1659x2212
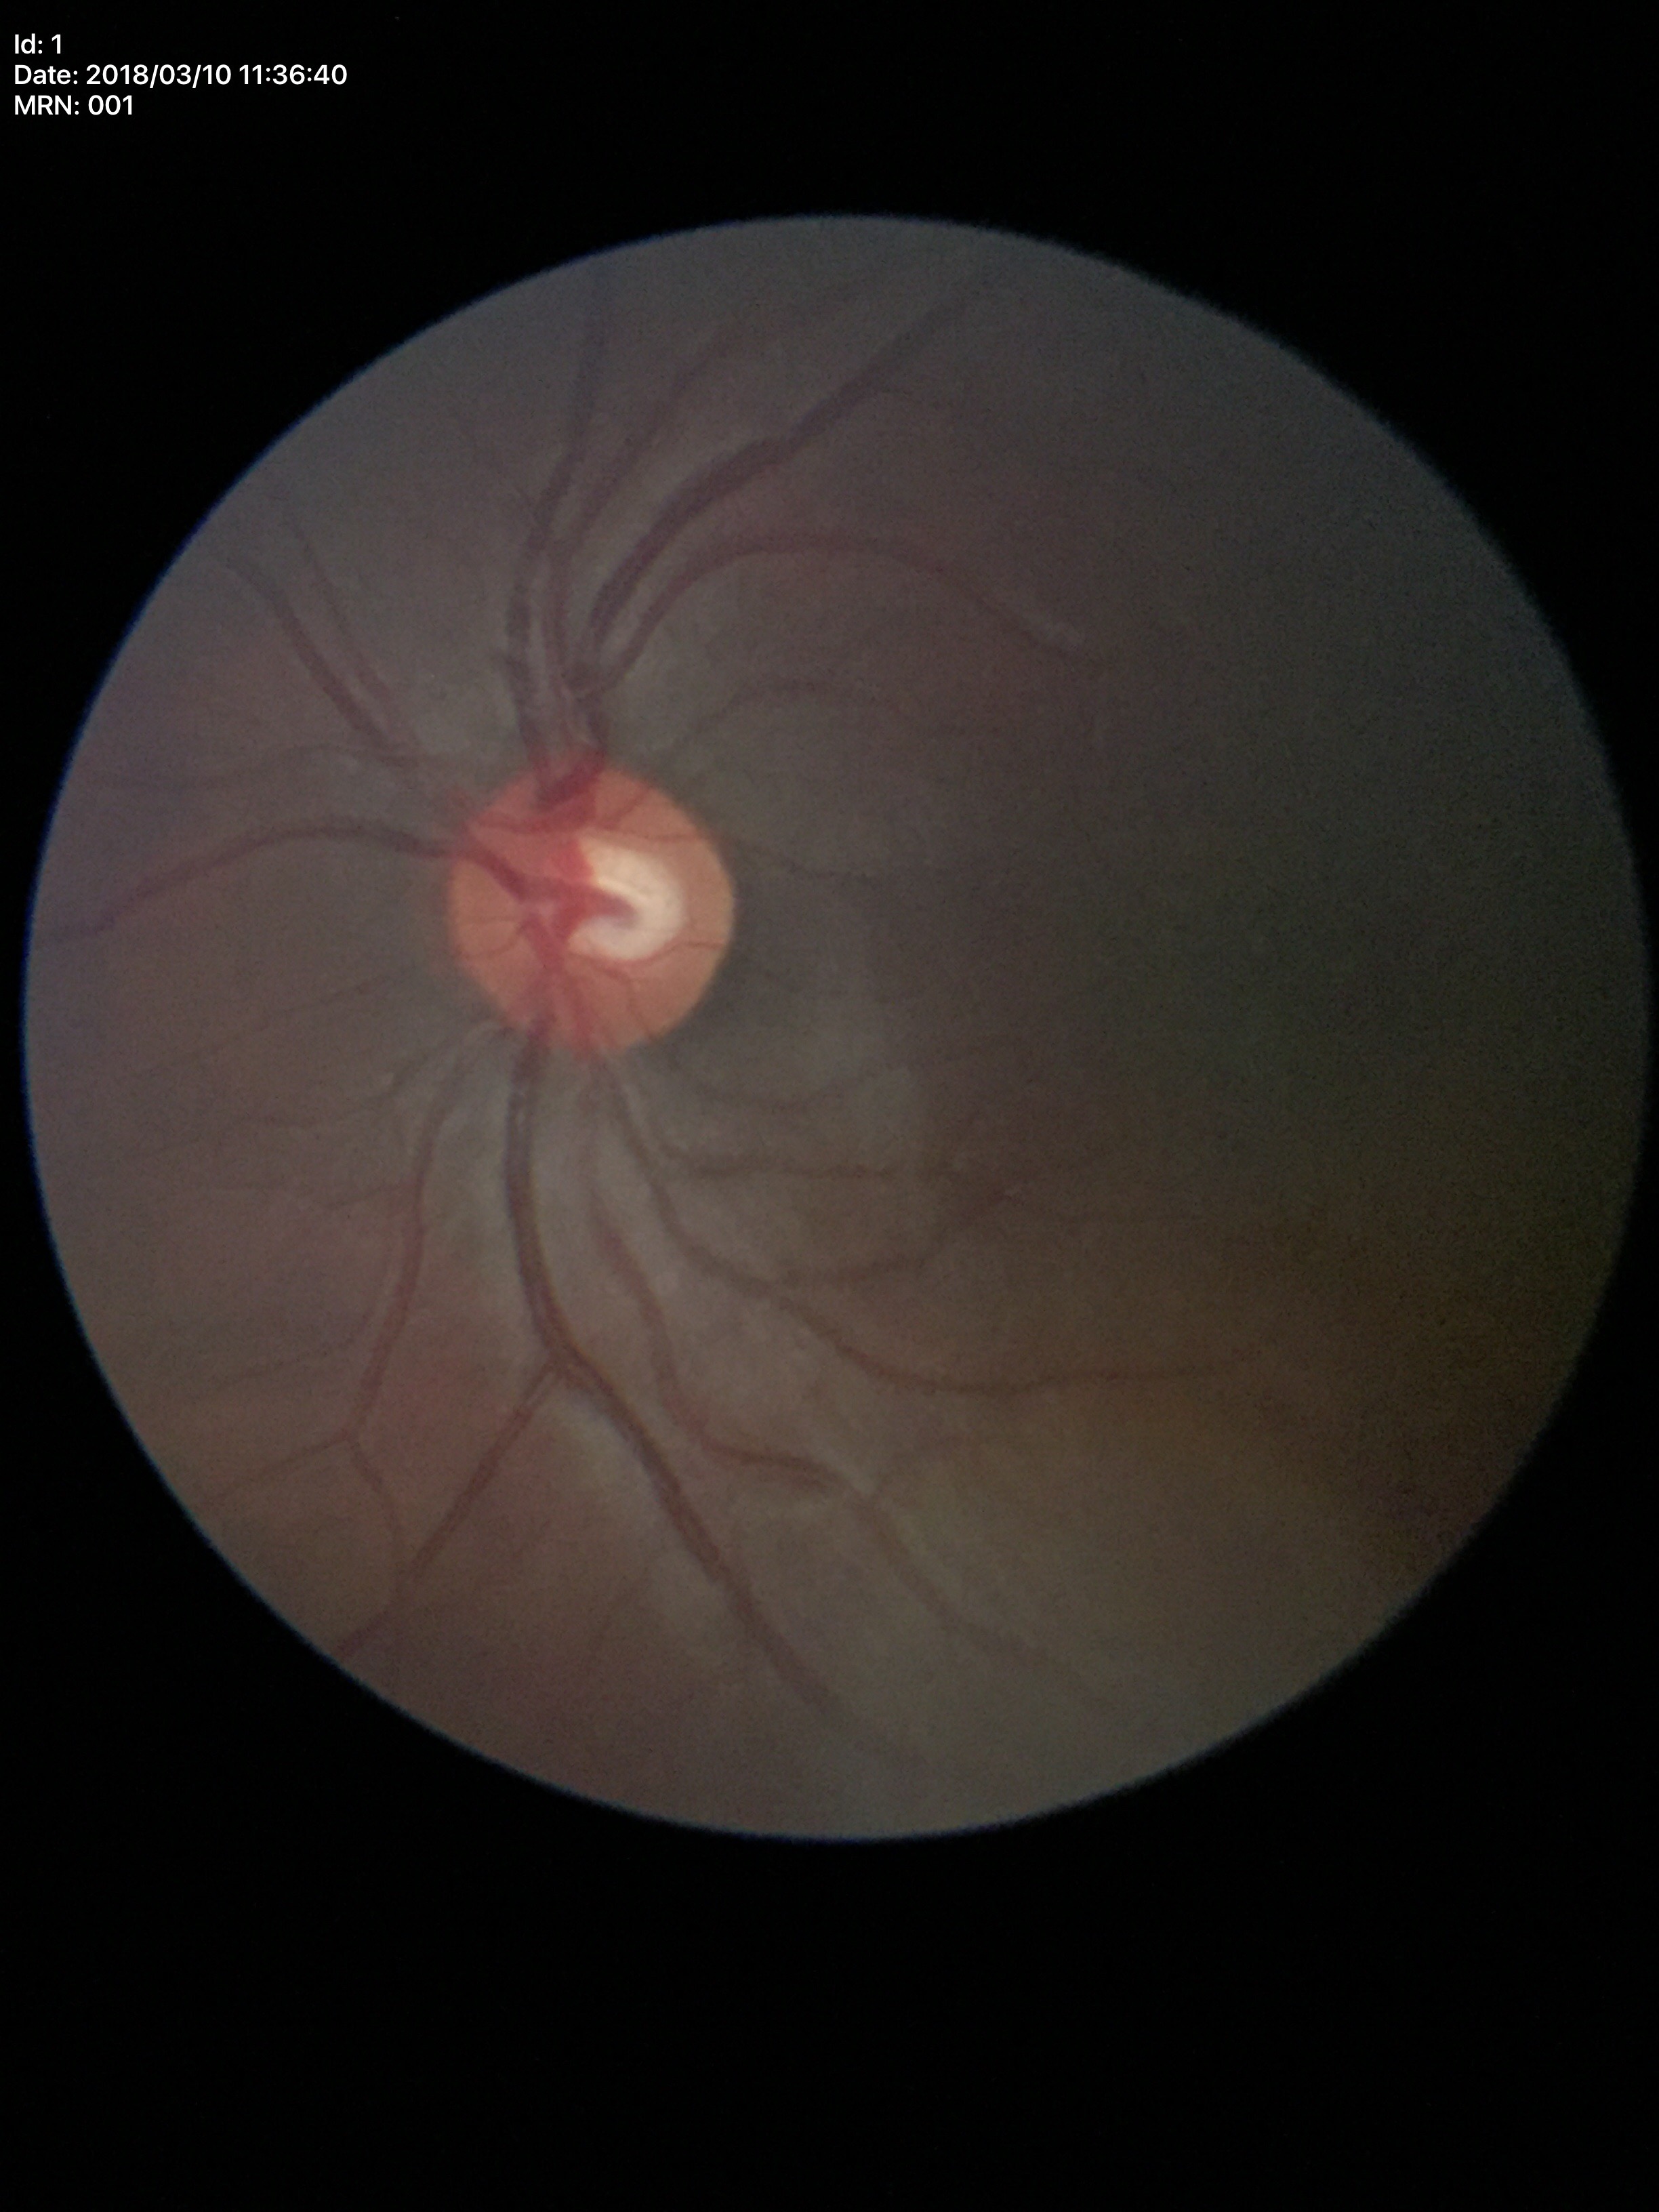
Glaucoma impression: no suspicious findings (5/5 ophthalmologists in agreement). Vertical cup-disc ratio of 0.50. Horizontal cup-to-disc ratio: 0.59.